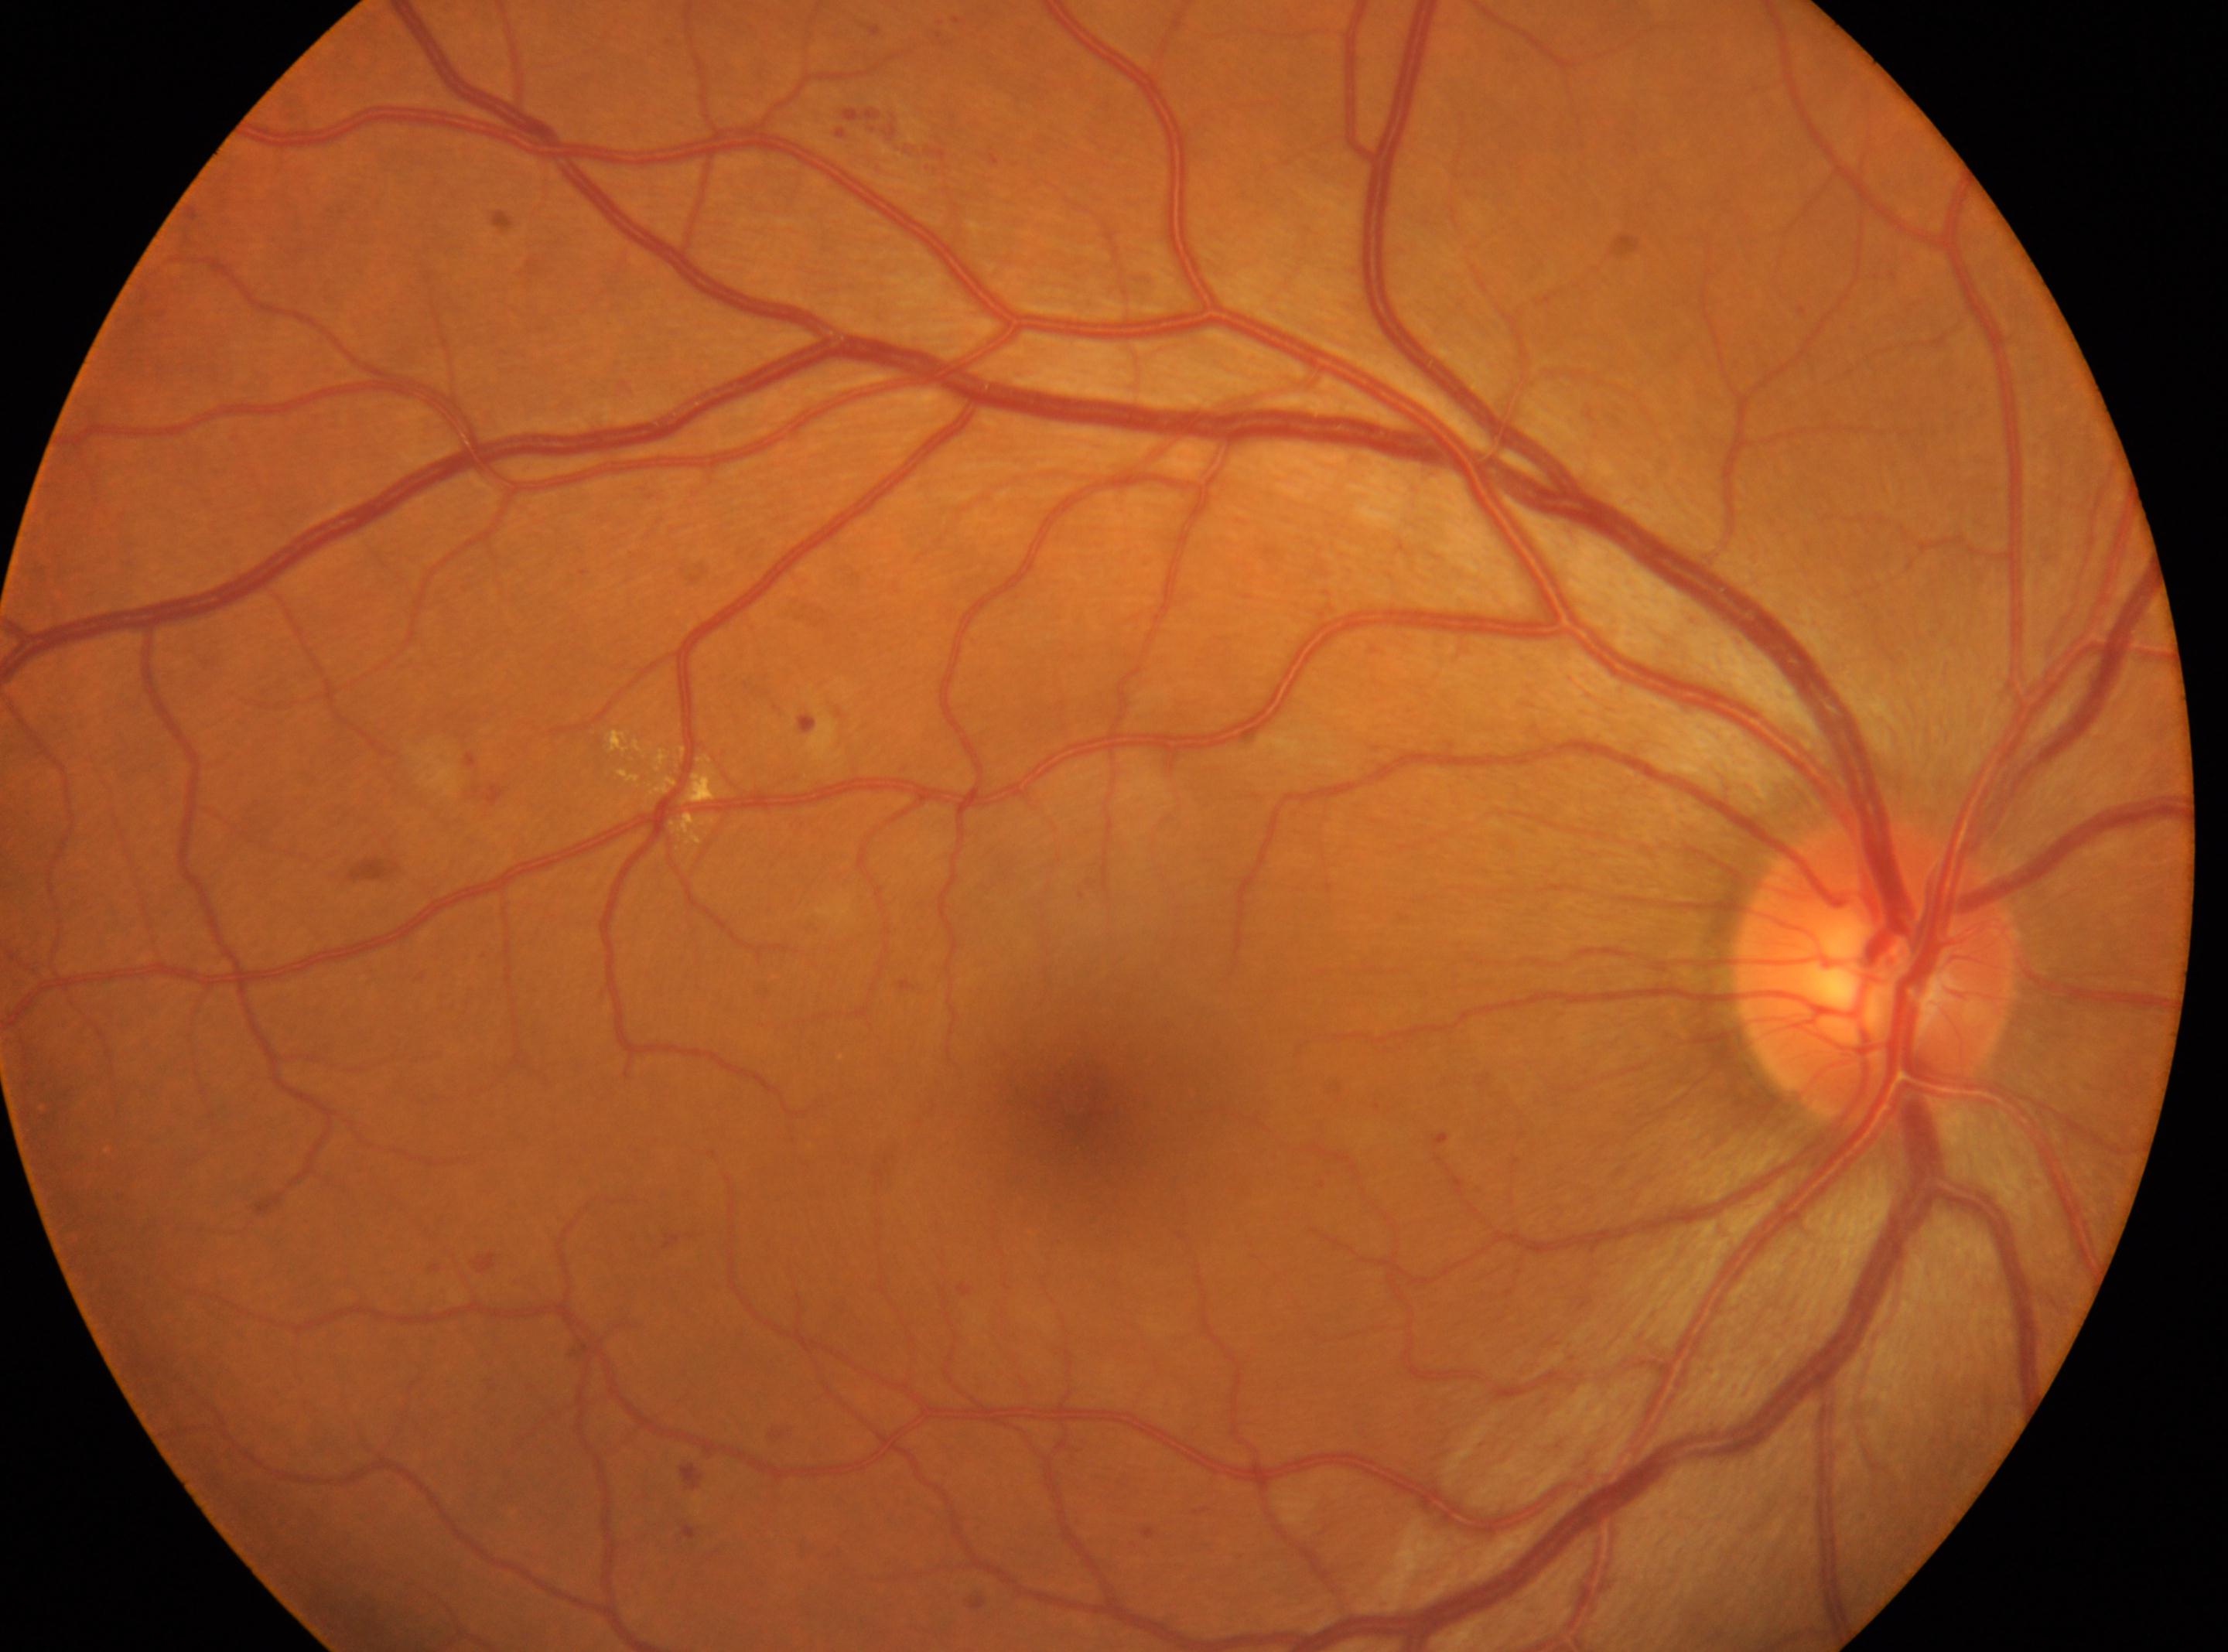 {
  "optic_disc": "x=1875, y=971",
  "eye": "right",
  "dr_grade": "moderate non-proliferative diabetic retinopathy (grade 2)",
  "fovea": "x=1074, y=1100"
}